45-degree field of view, 2212x1659px.
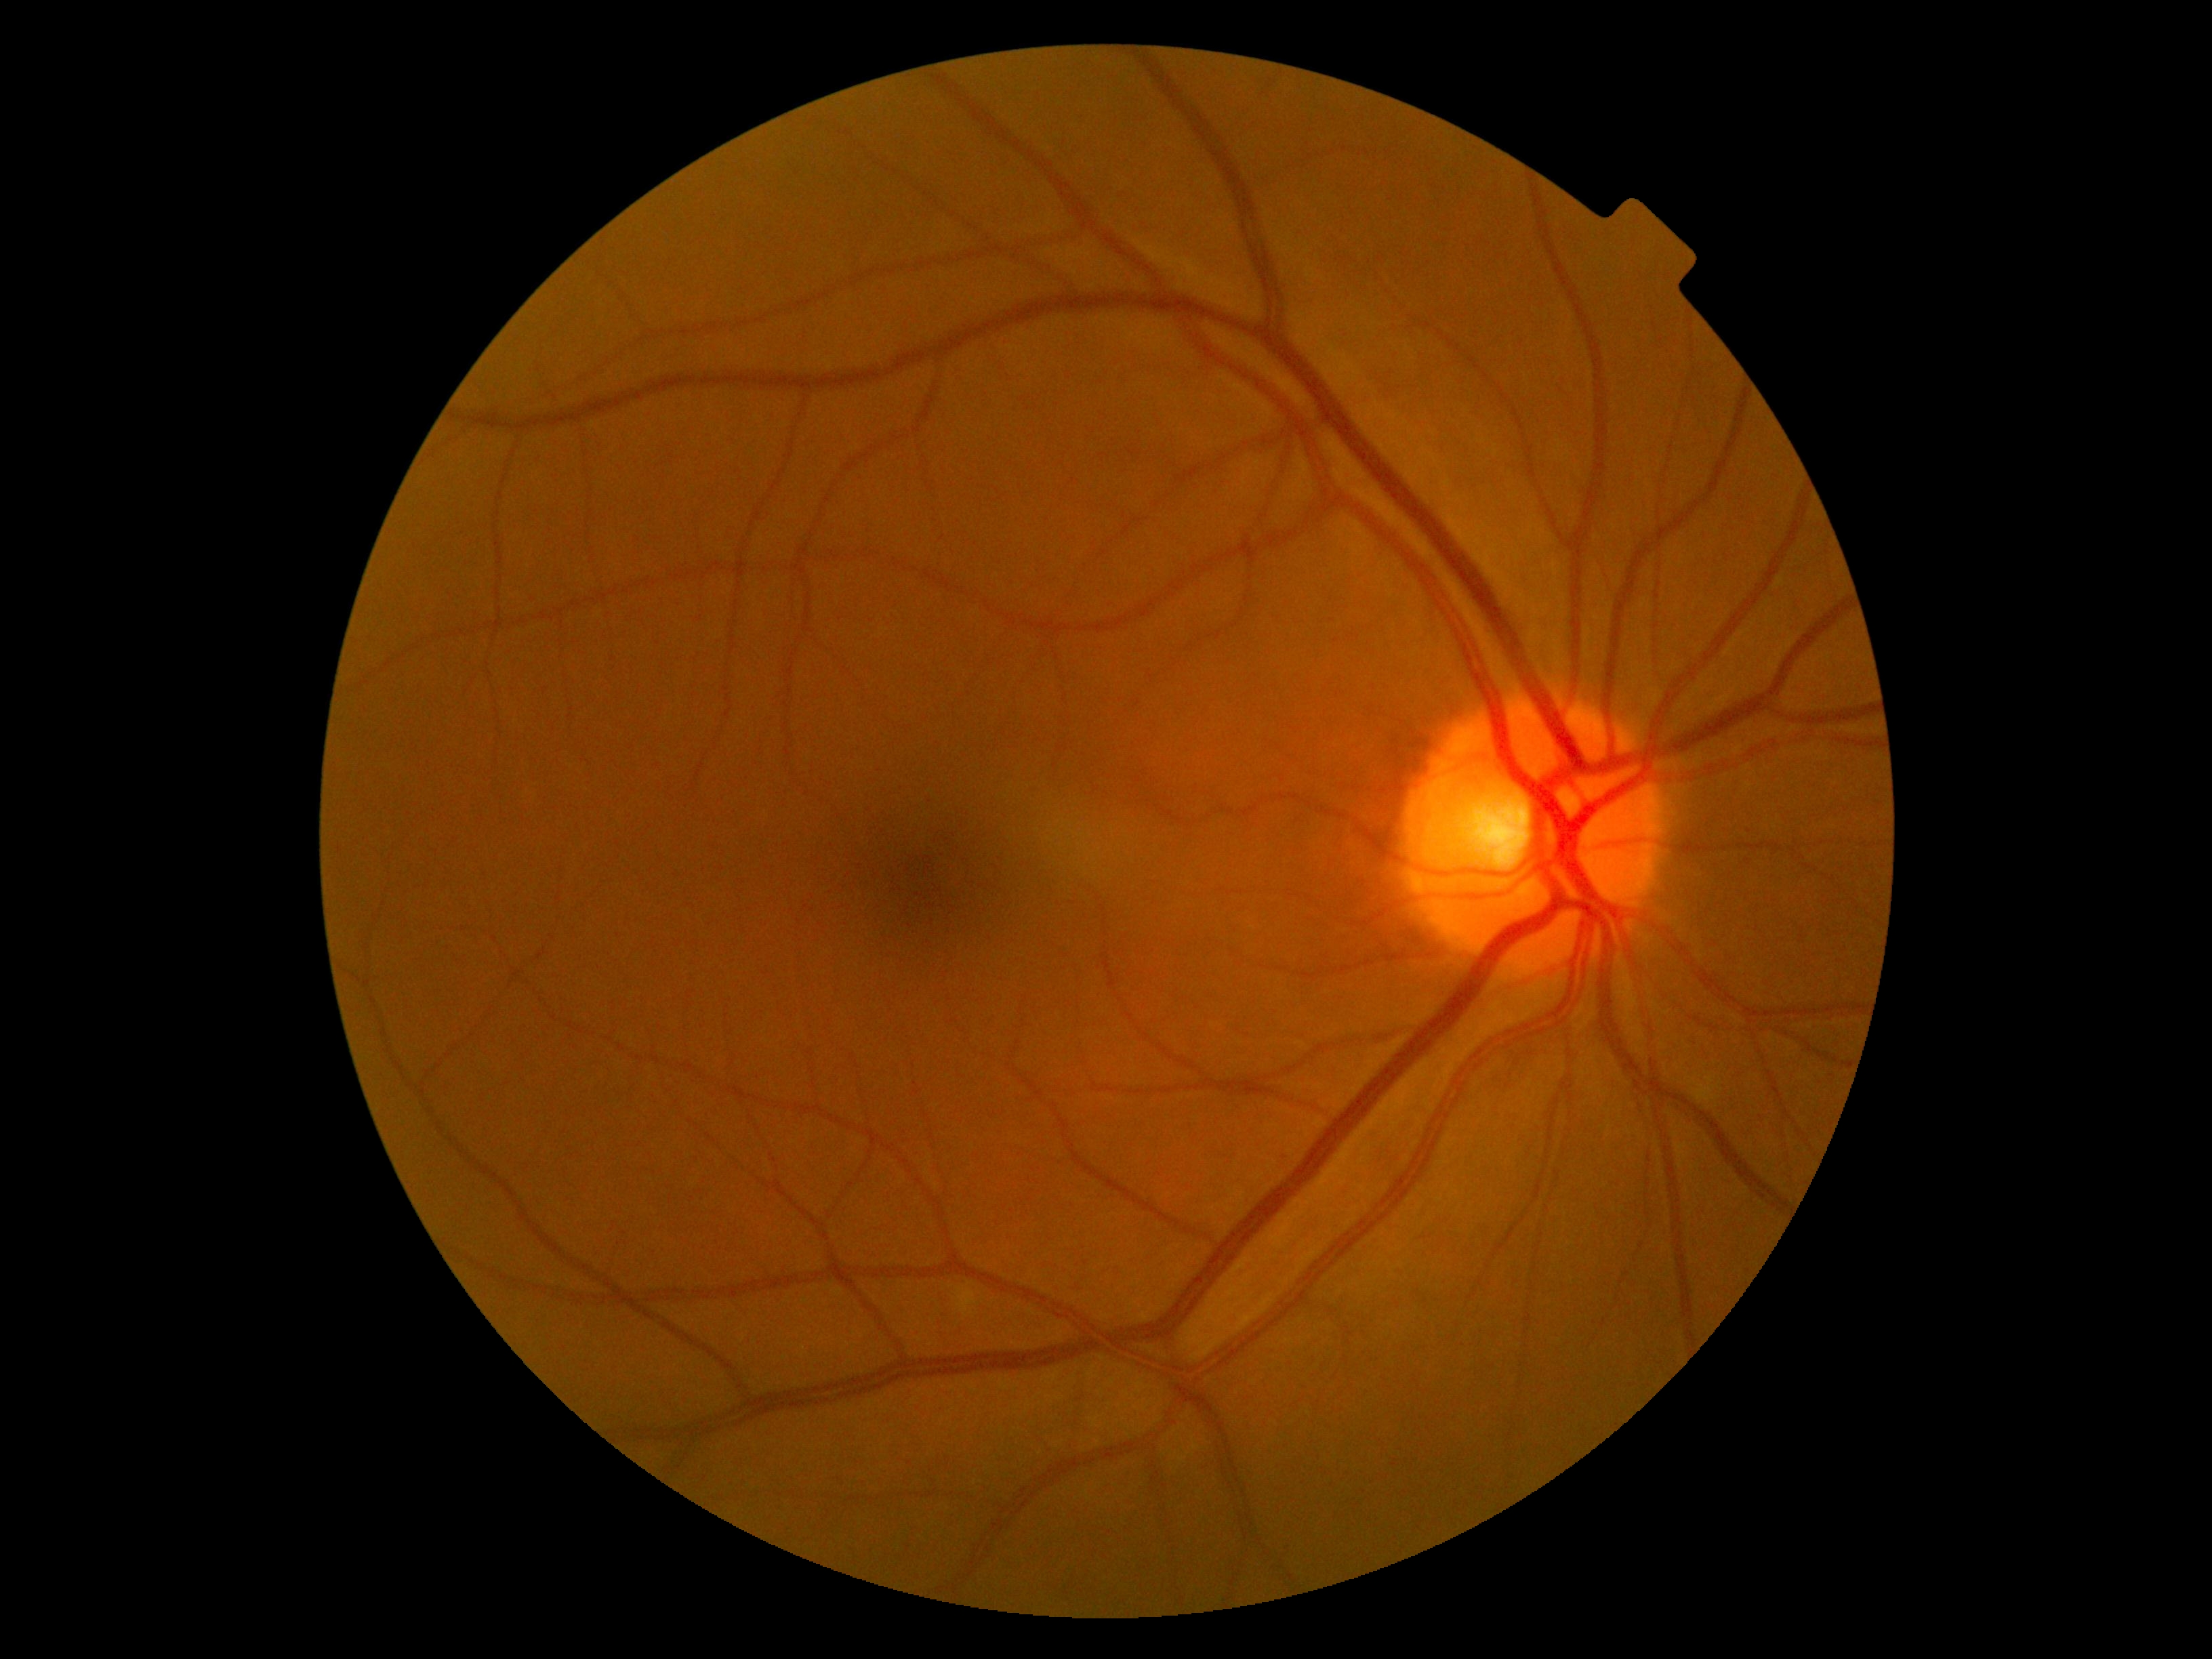

No DR findings. Diabetic retinopathy severity is grade 0 (no apparent retinopathy).